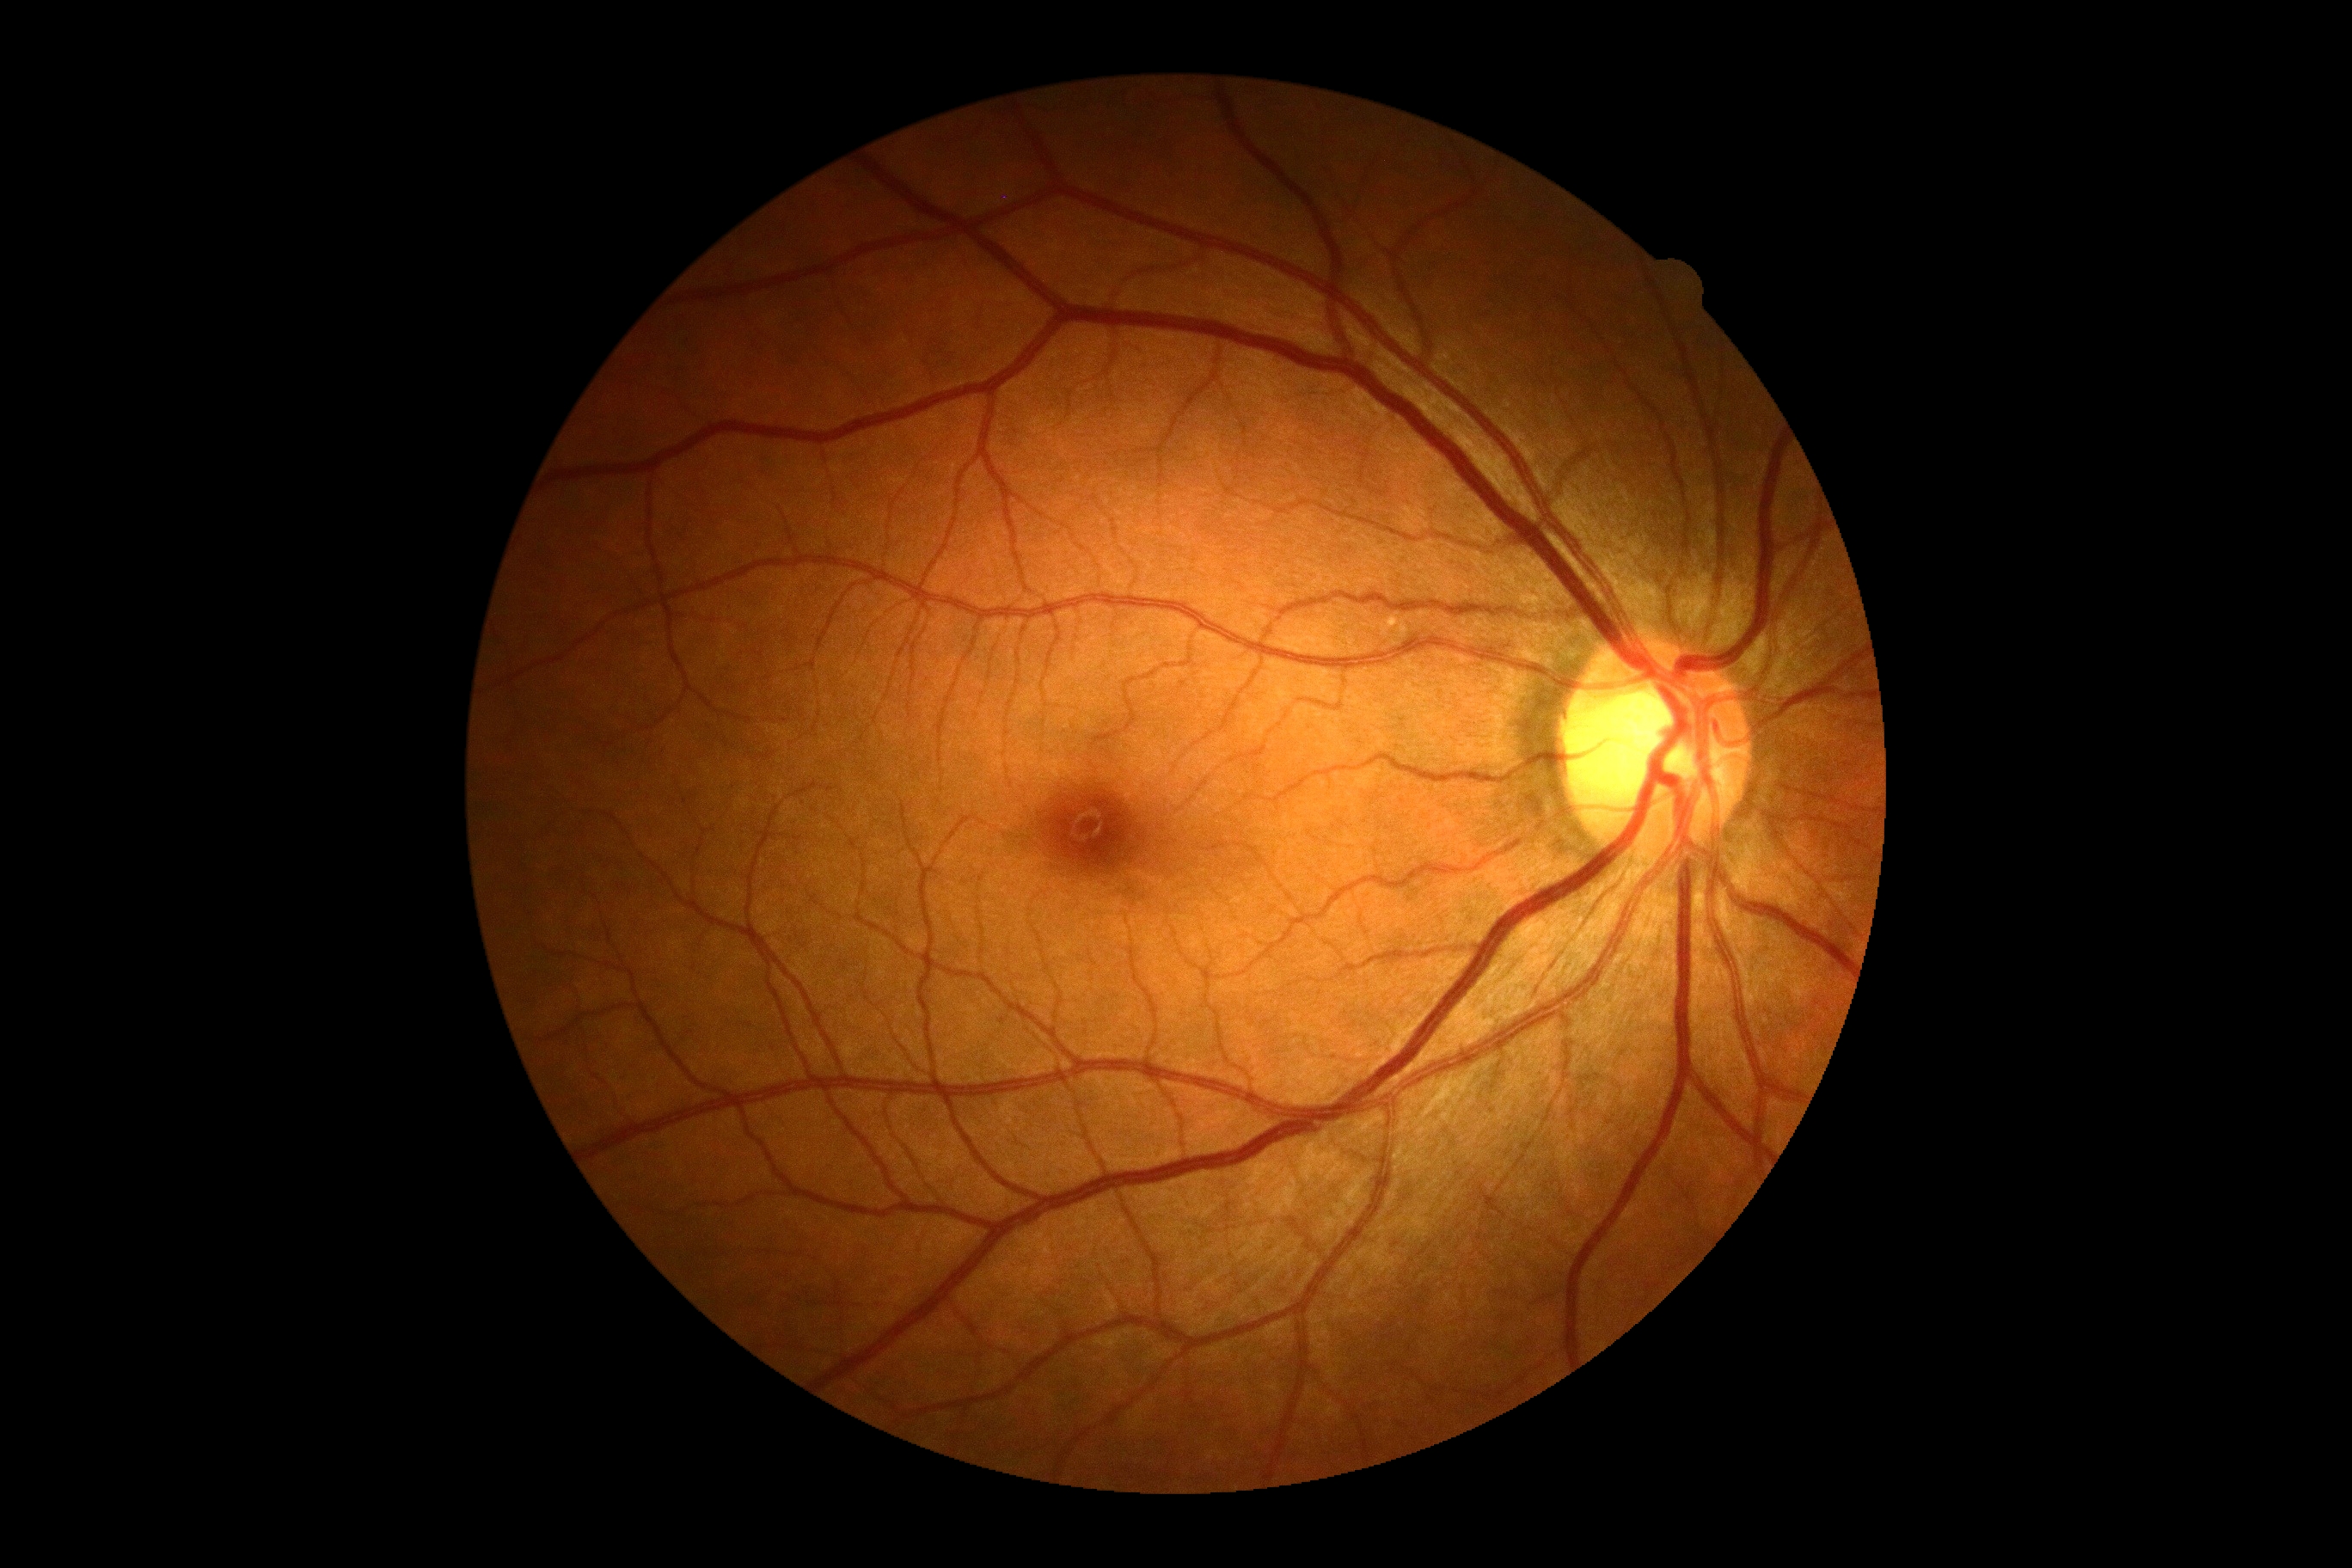

Diabetic retinopathy (DR) is grade 0.
No signs of diabetic retinopathy.